Posterior pole photograph
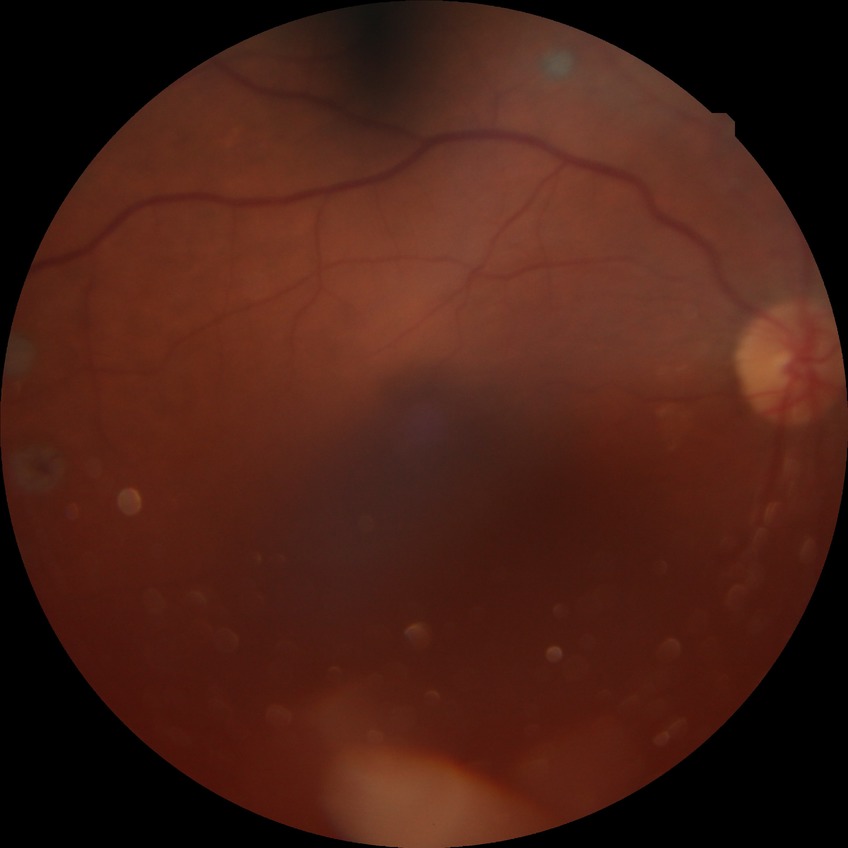

Diabetic retinopathy severity: proliferative diabetic retinopathy.